2212x1659px: 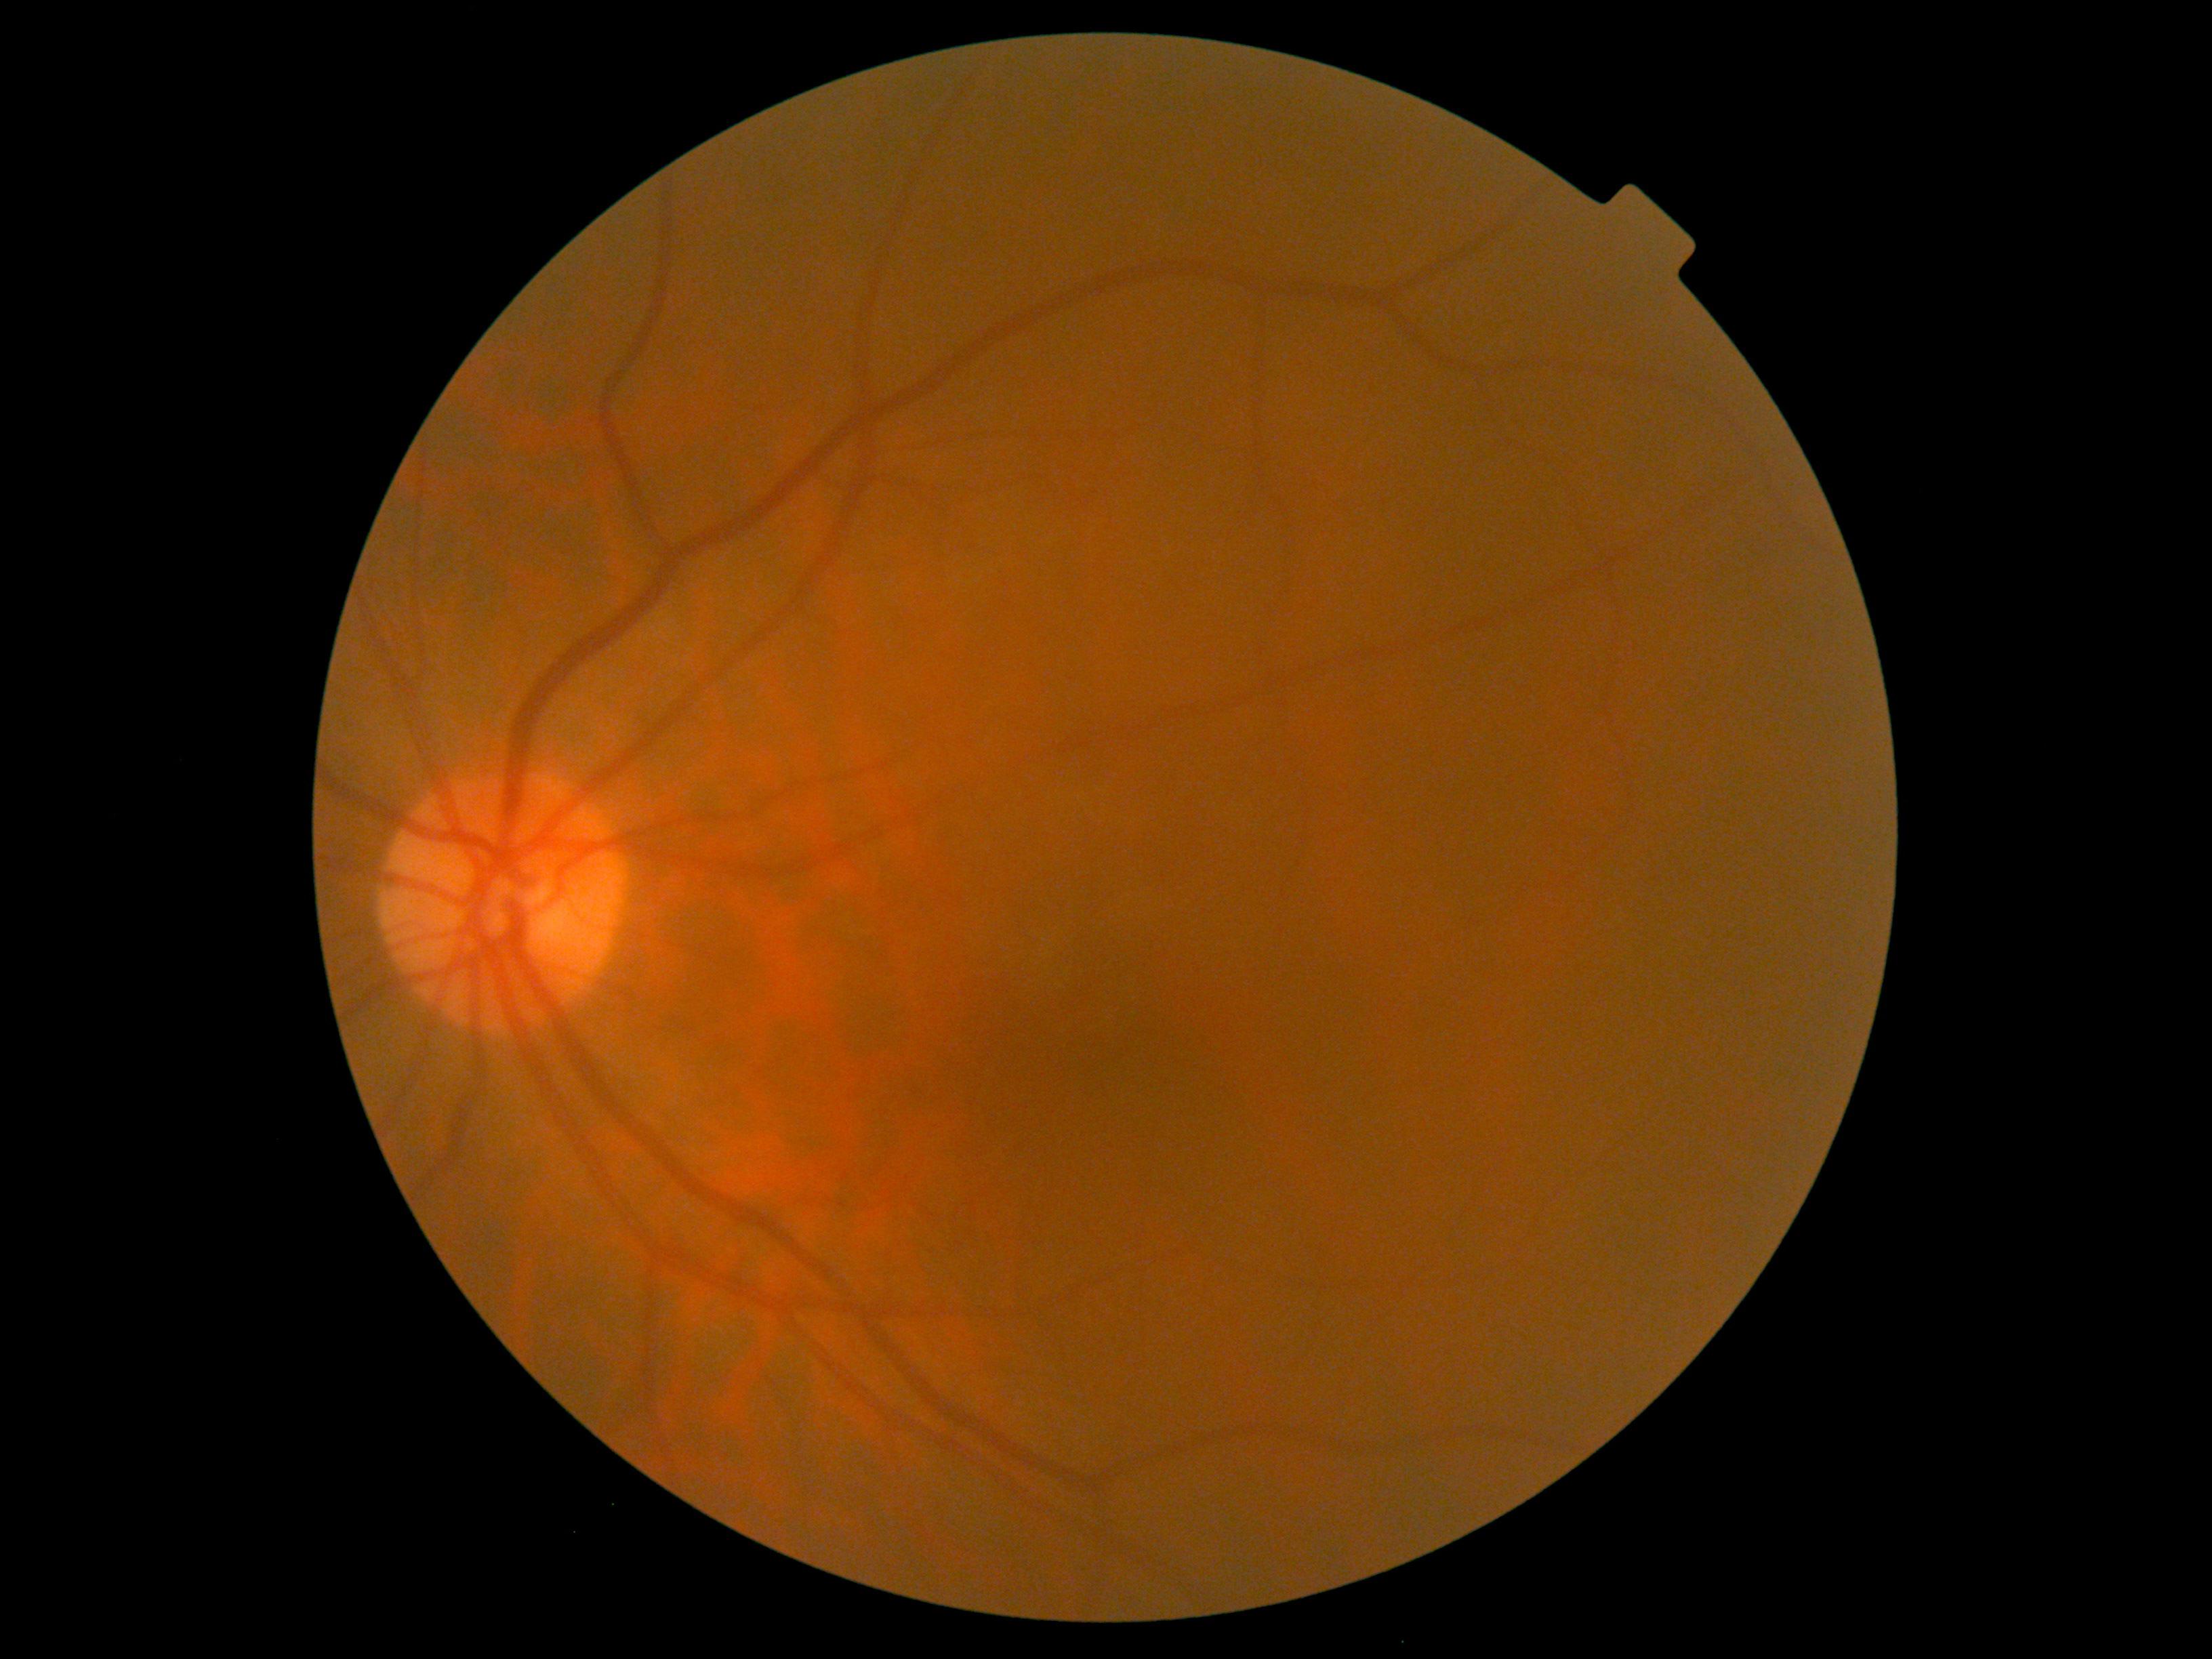
retinopathy@0/4; DR impression@negative for DR.